Camera: NIDEK AFC-230, modified Davis grading
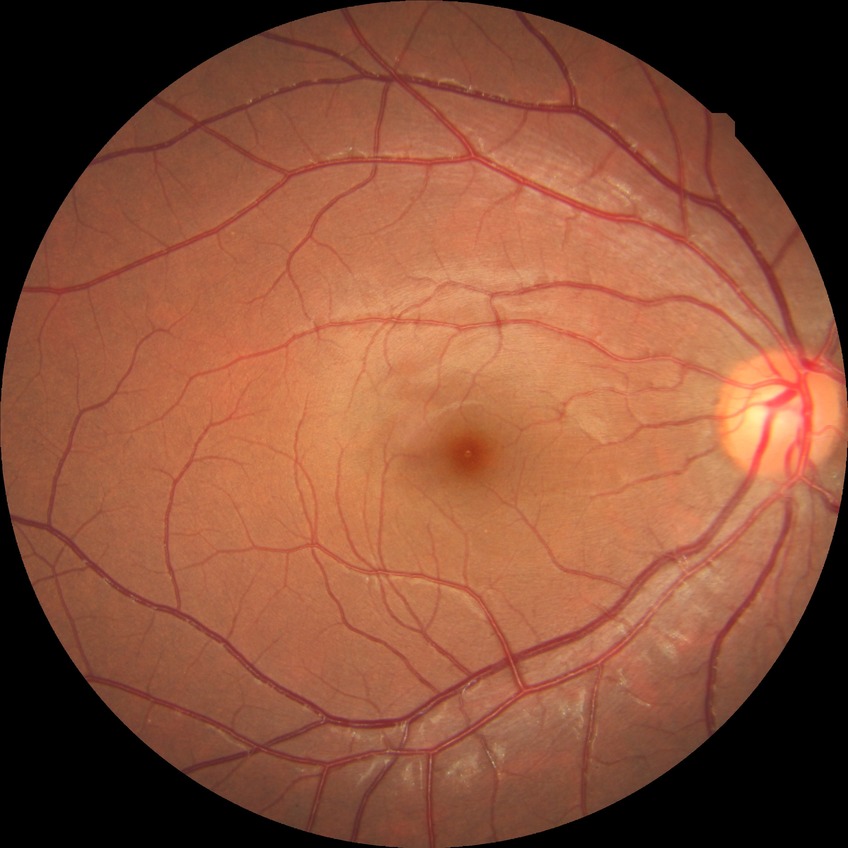
Diabetic retinopathy (DR) is no diabetic retinopathy (NDR).